45° field of view: 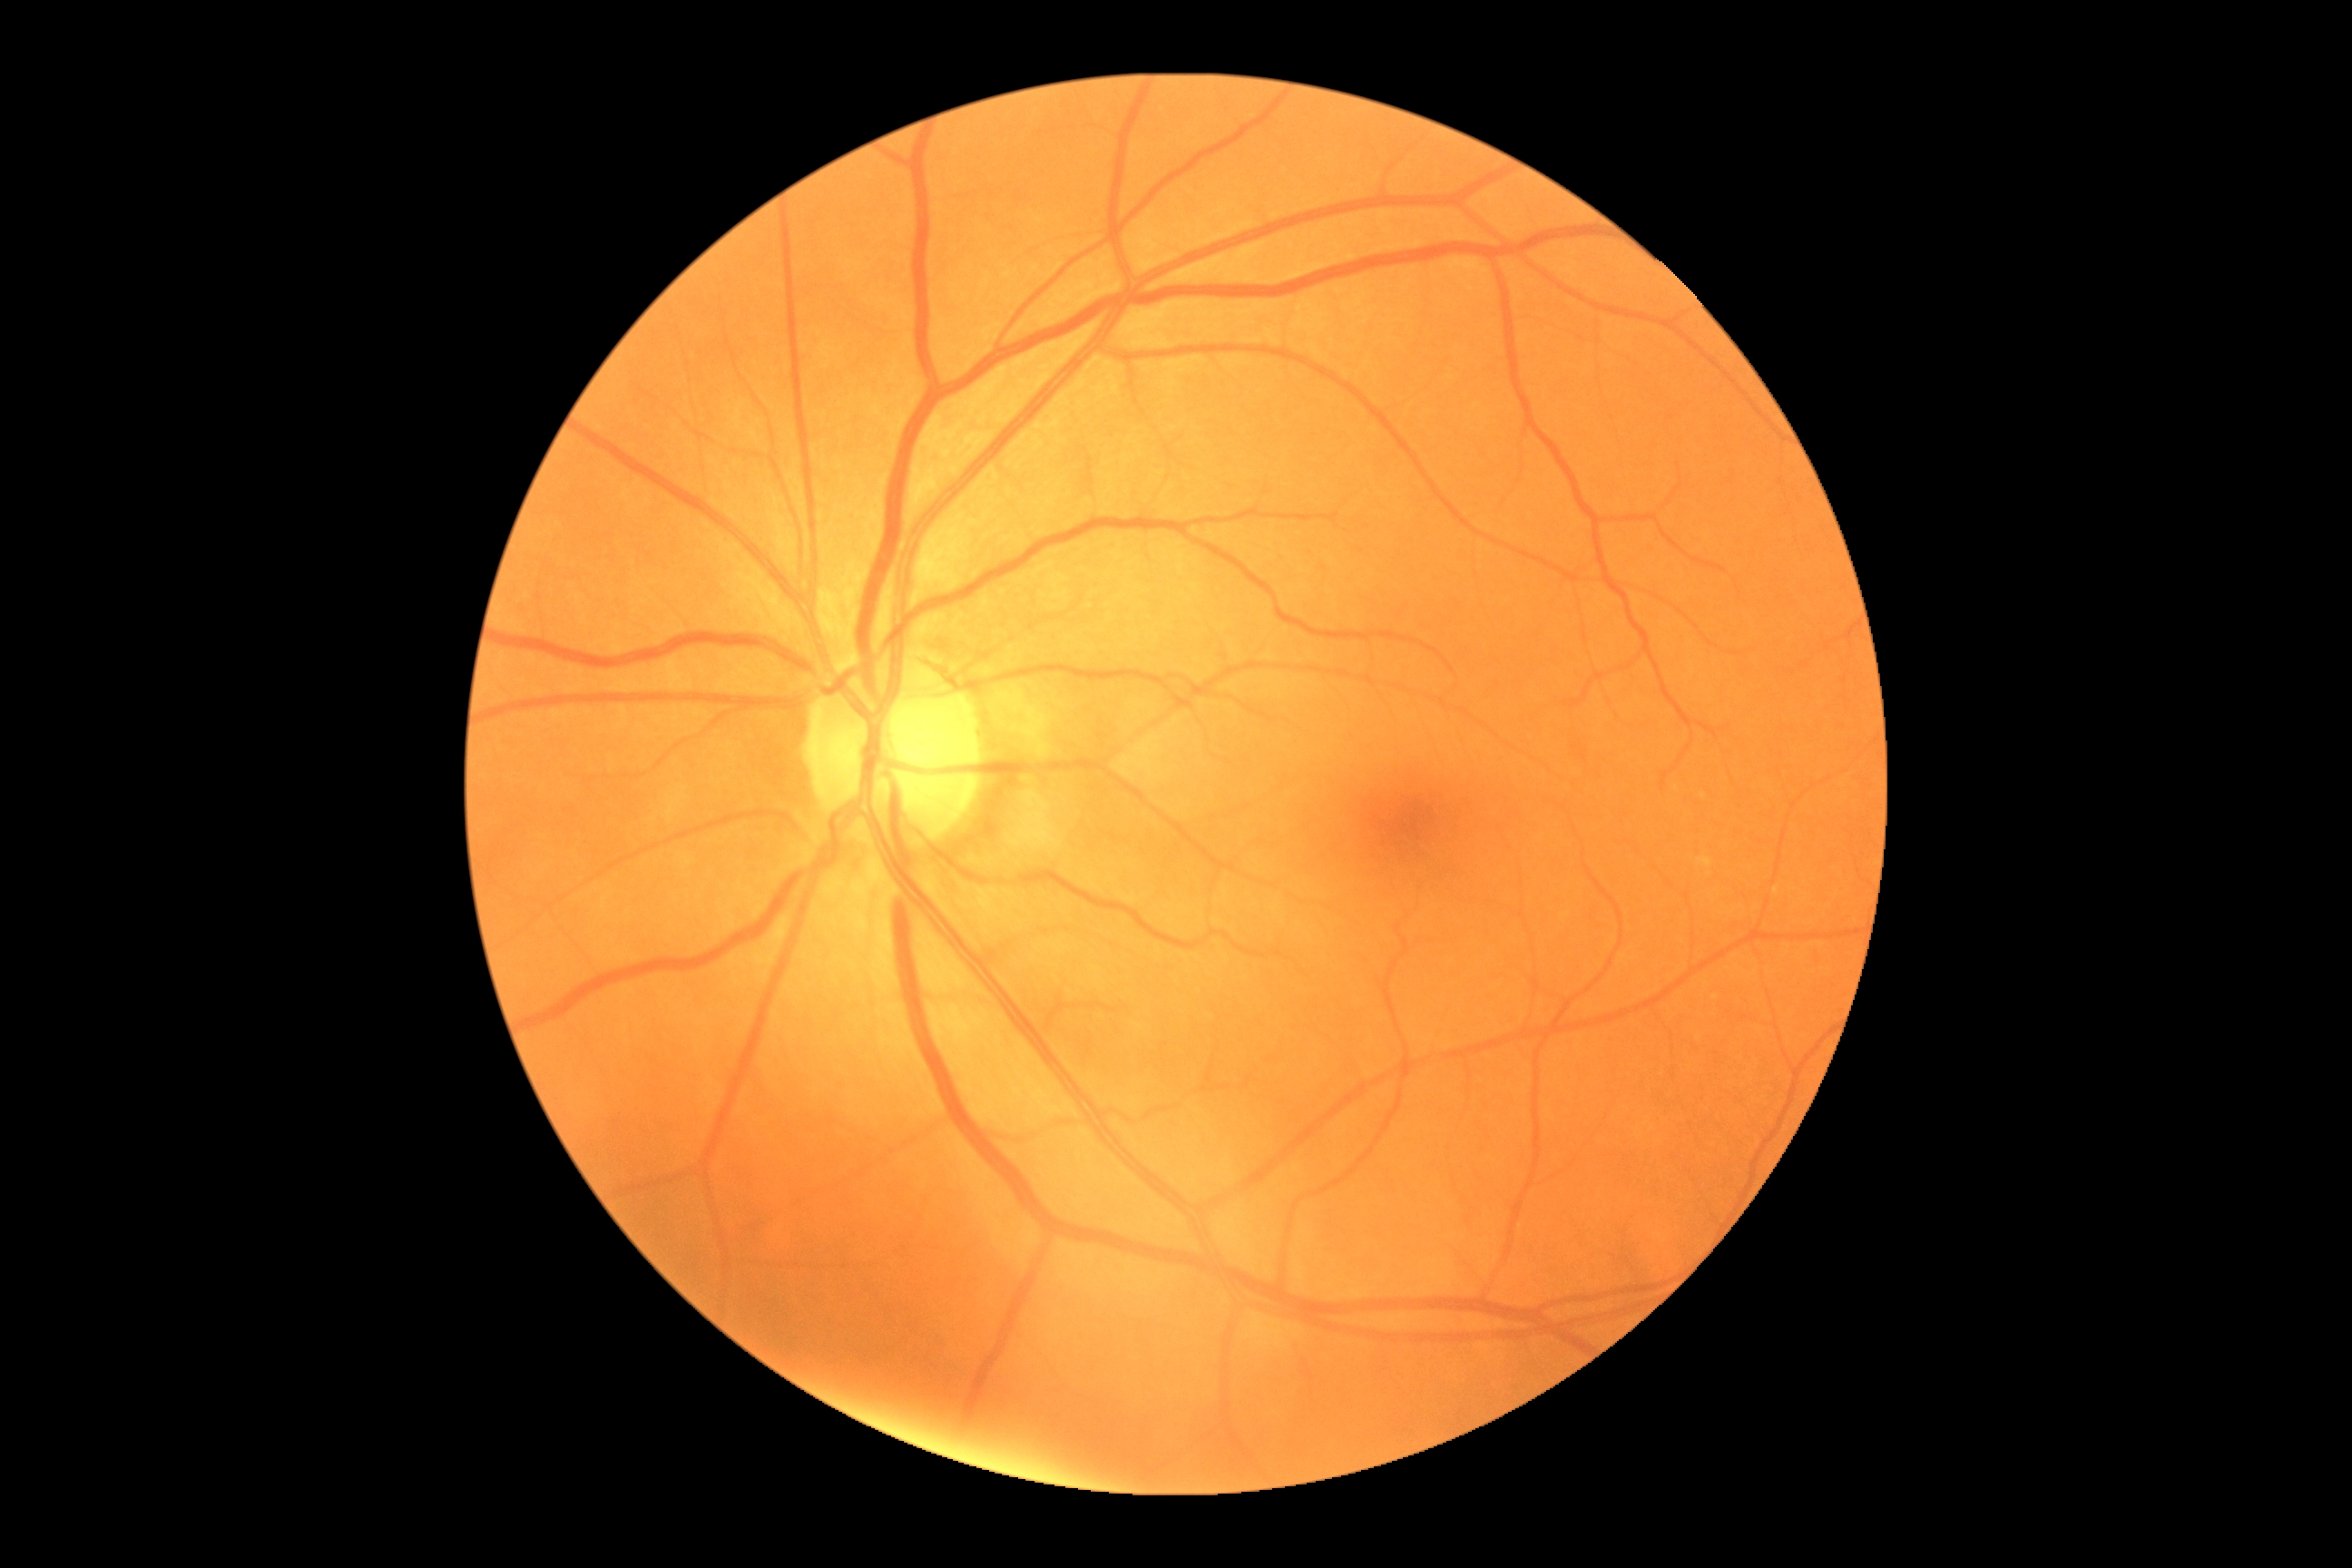

dr_grade: no apparent diabetic retinopathy (grade 0)